Bosch fundus camera; retinal fundus photograph:
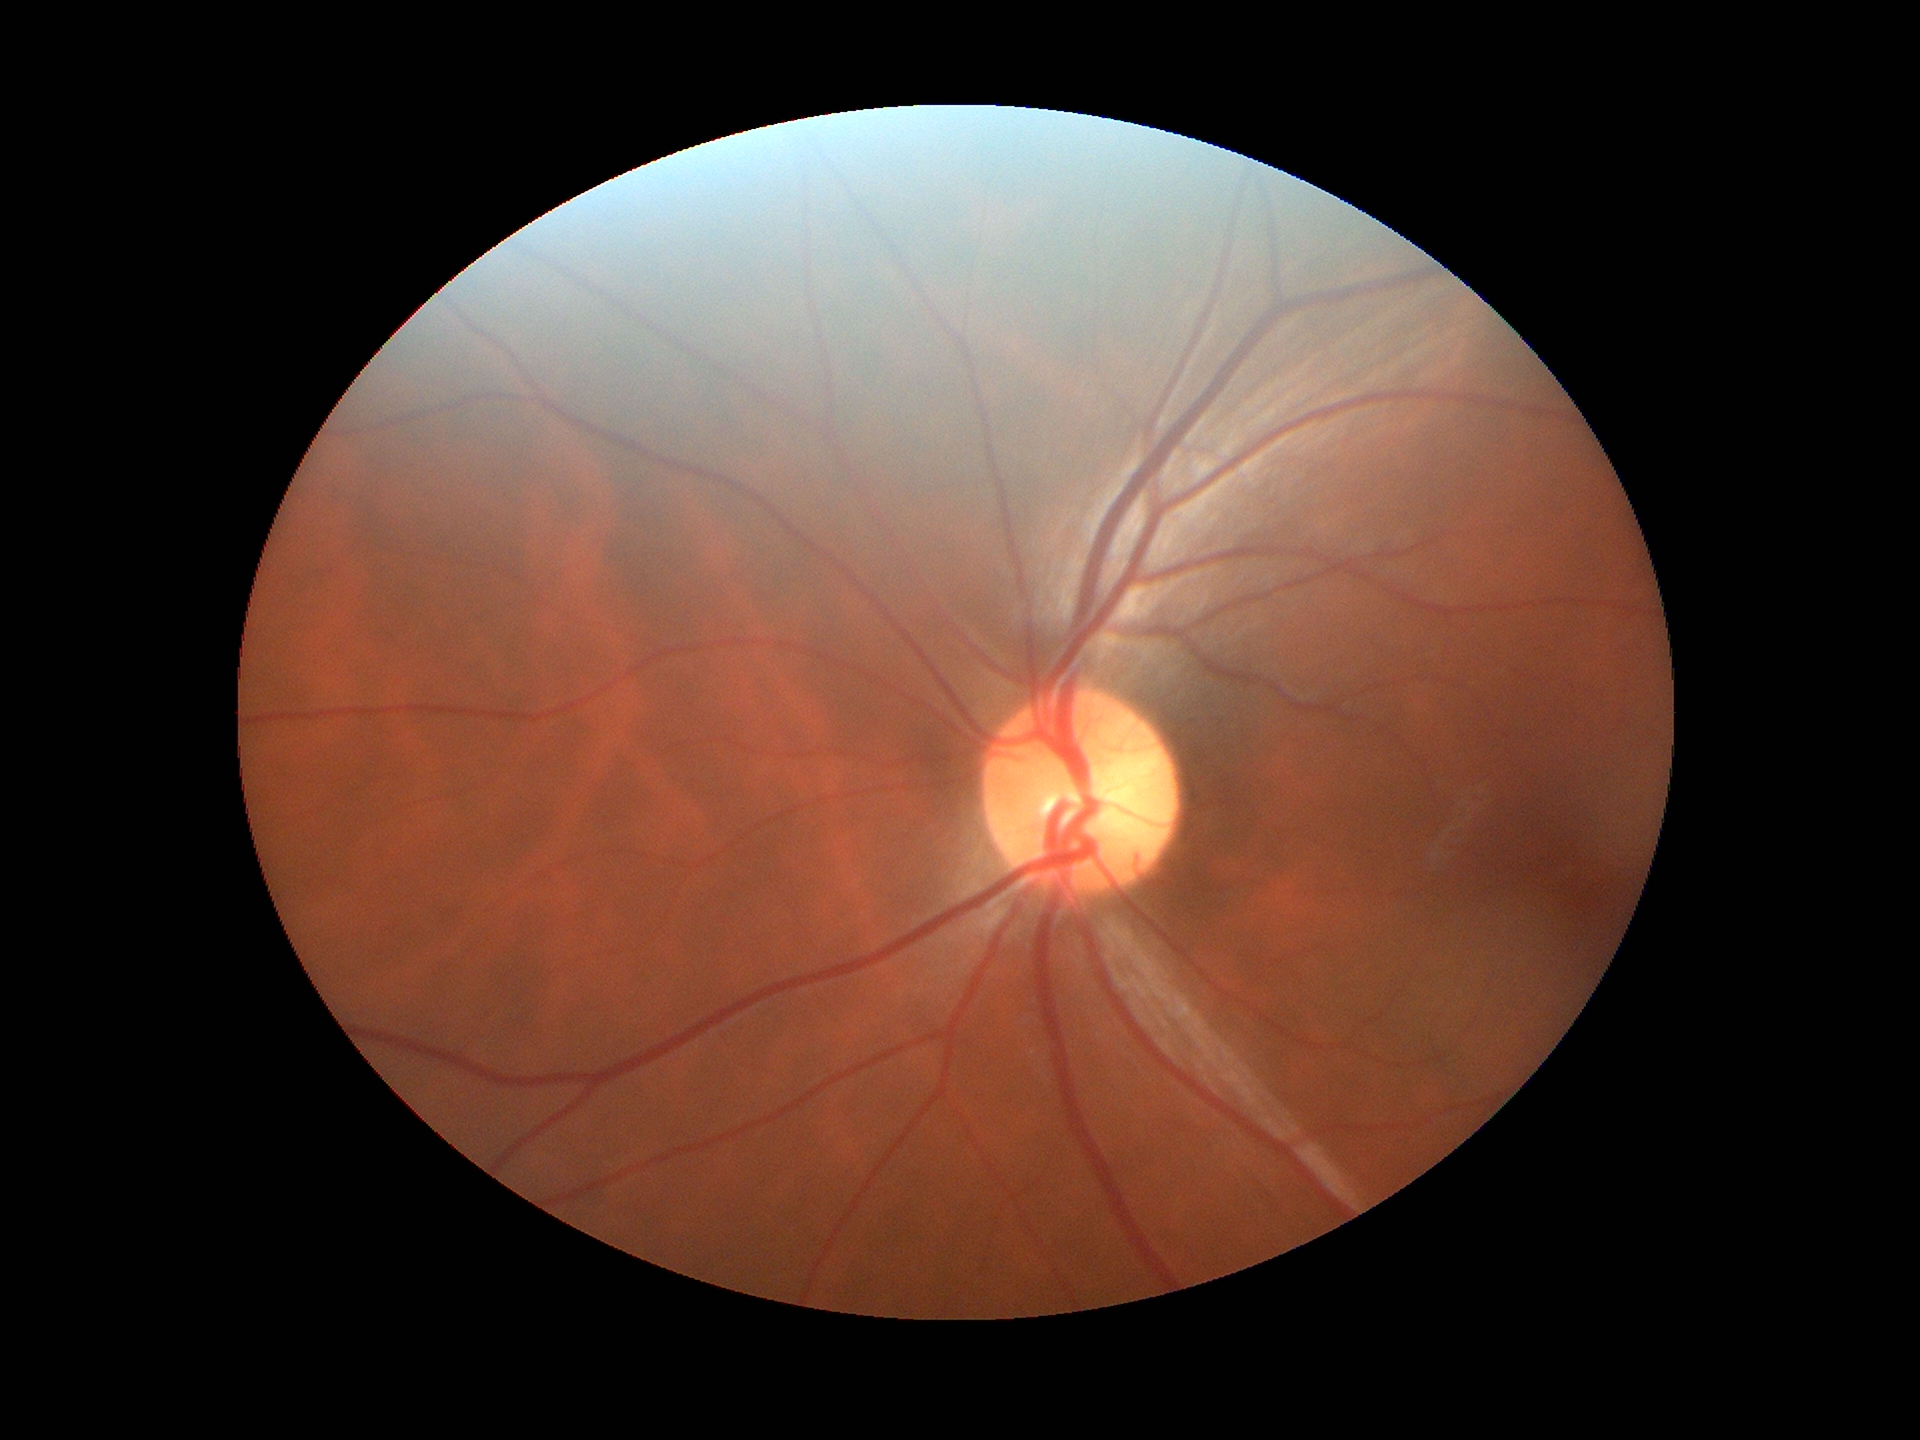
Glaucoma screening: negative. Vertical C/D ratio (VCDR): 0.47. Horizontal cup-disc ratio (HCDR) is 0.48.